Pediatric wide-field fundus photograph. Camera: Natus RetCam Envision (130° FOV)
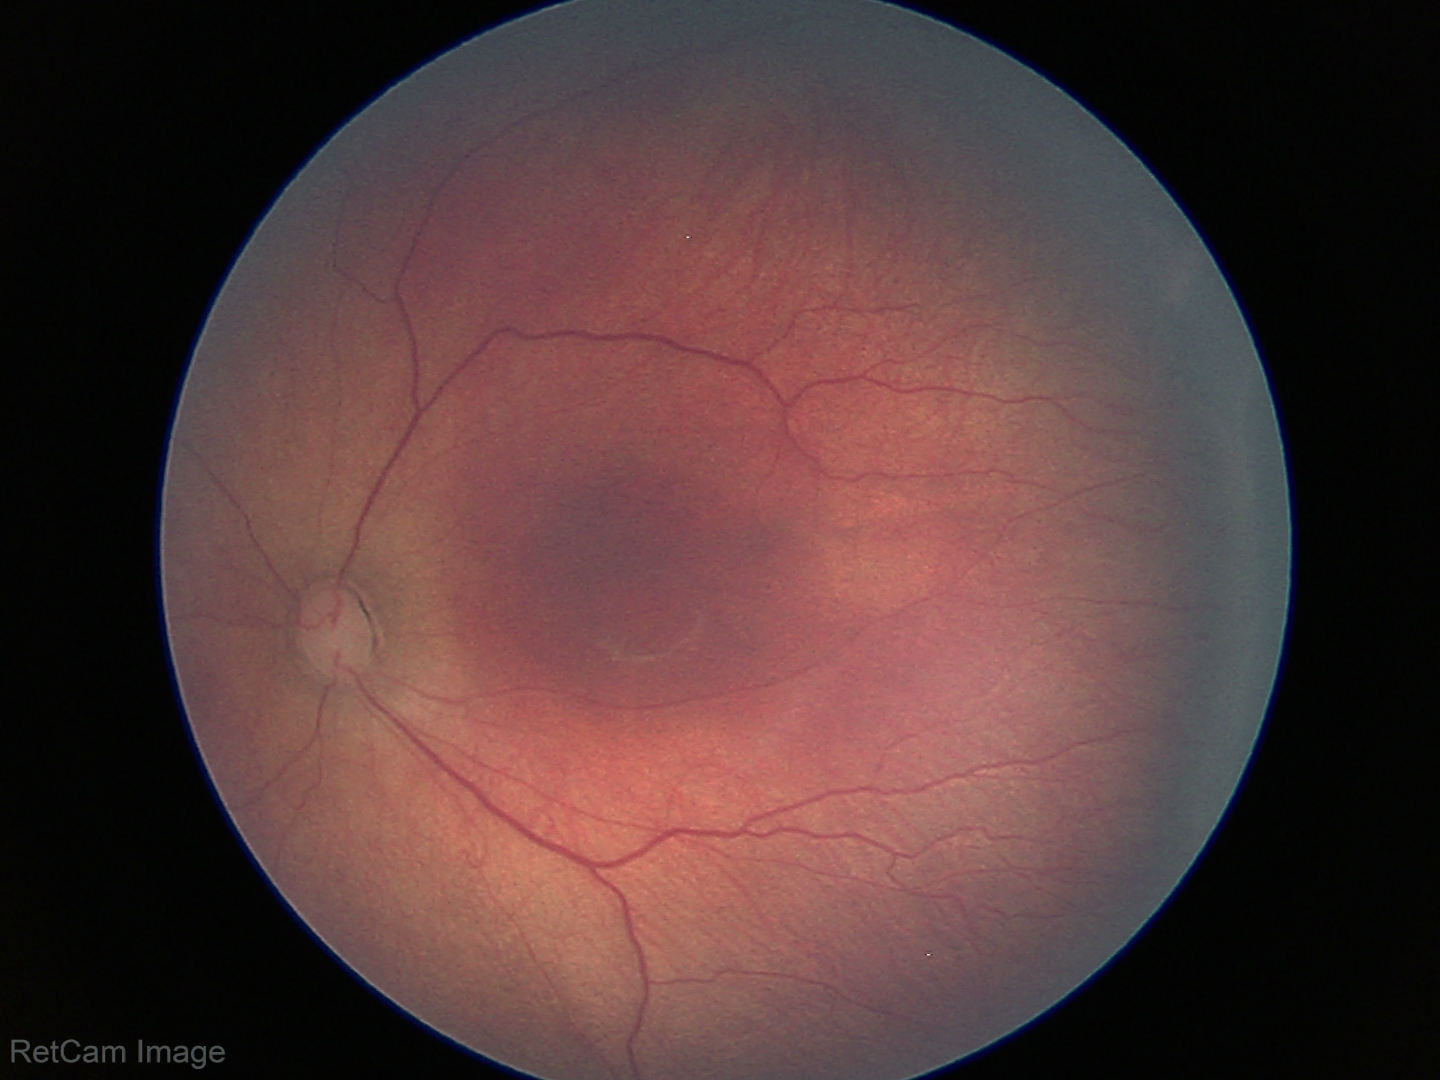

Q: What is the plus-form classification?
A: no plus disease
Q: What is the screening diagnosis?
A: ROP stage 3